Infant wide-field retinal image: 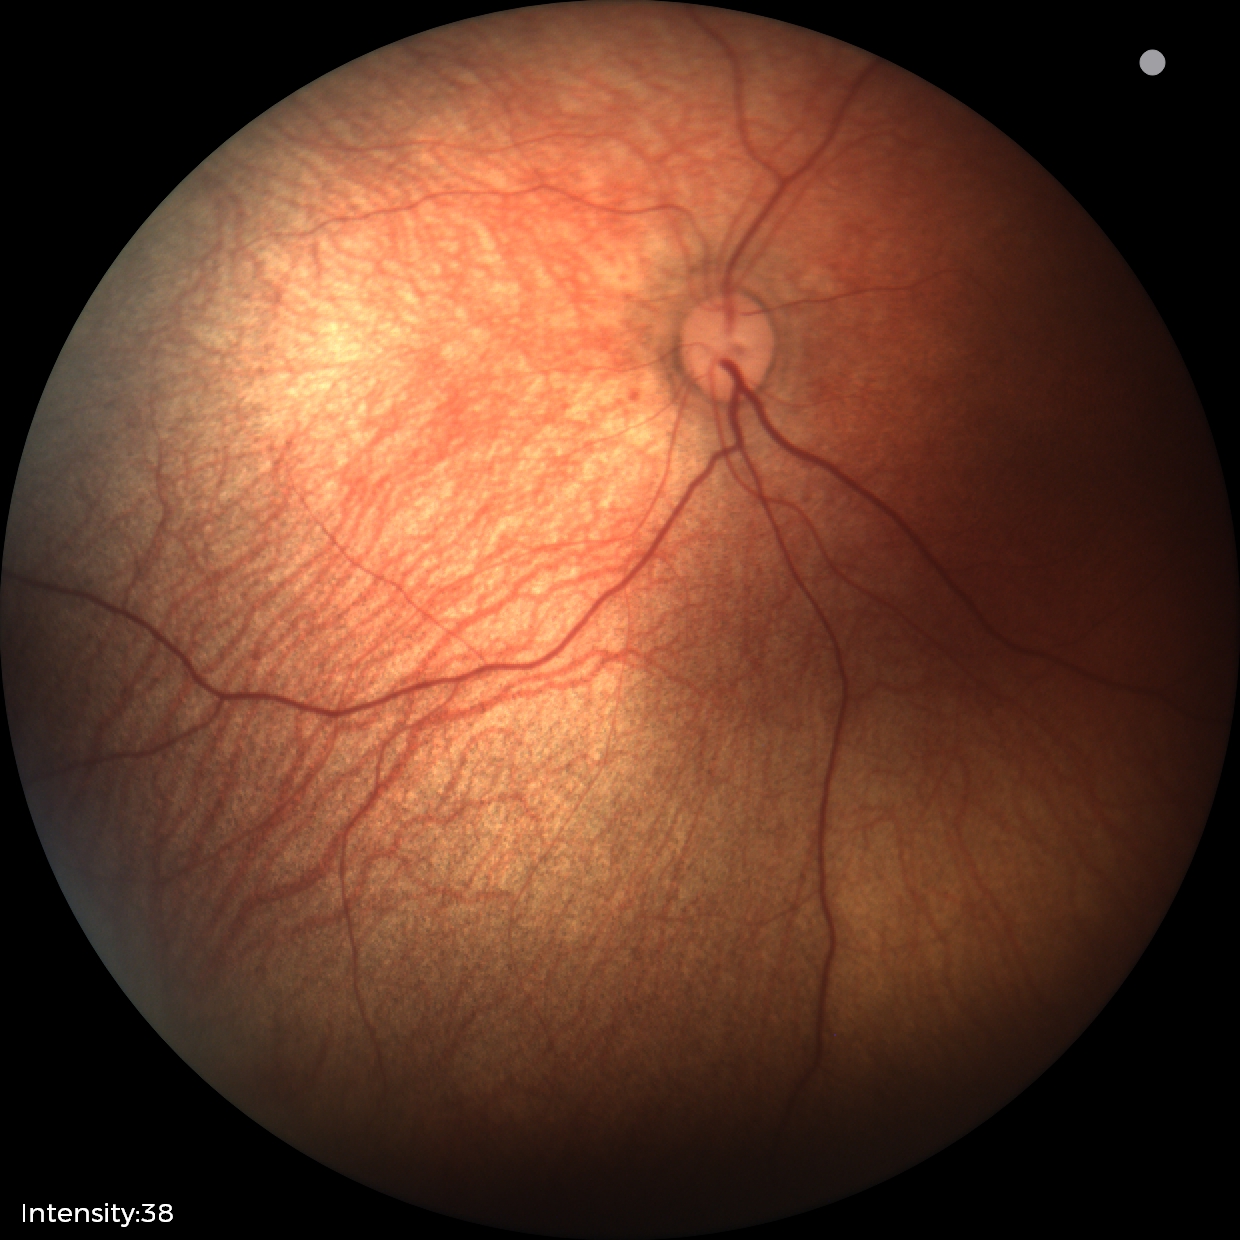
Examination with physiological retinal findings.